Image size 1240x1240. Phoenix ICON wide-field infant fundus image
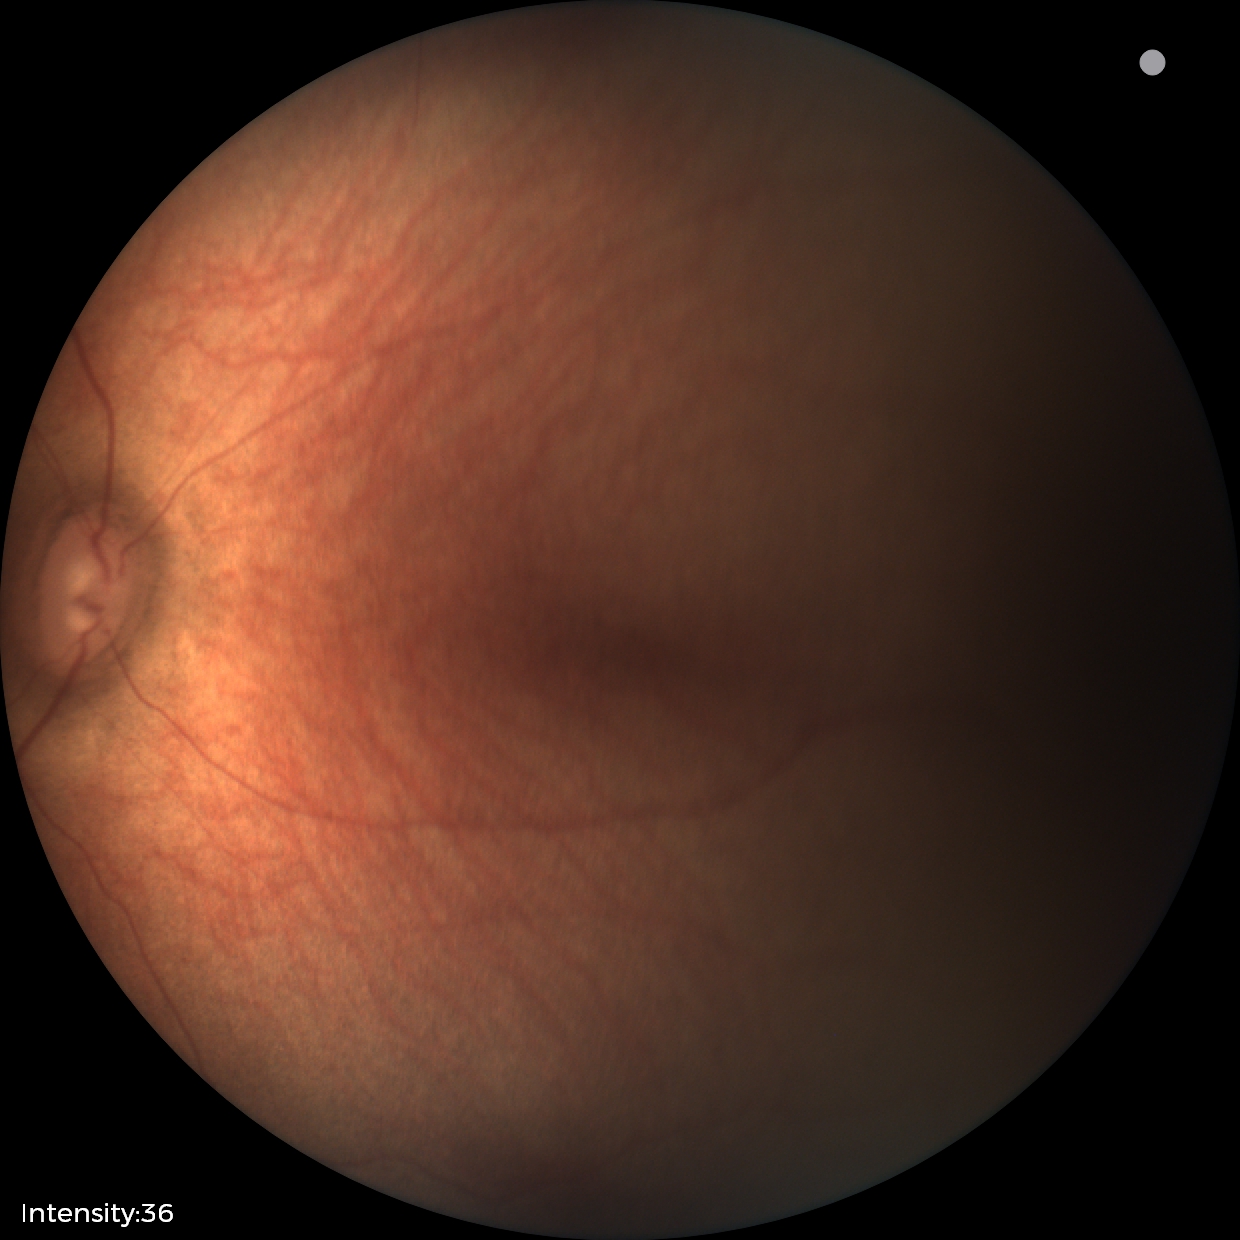
Examination with physiological retinal findings.